Davis DR grading — 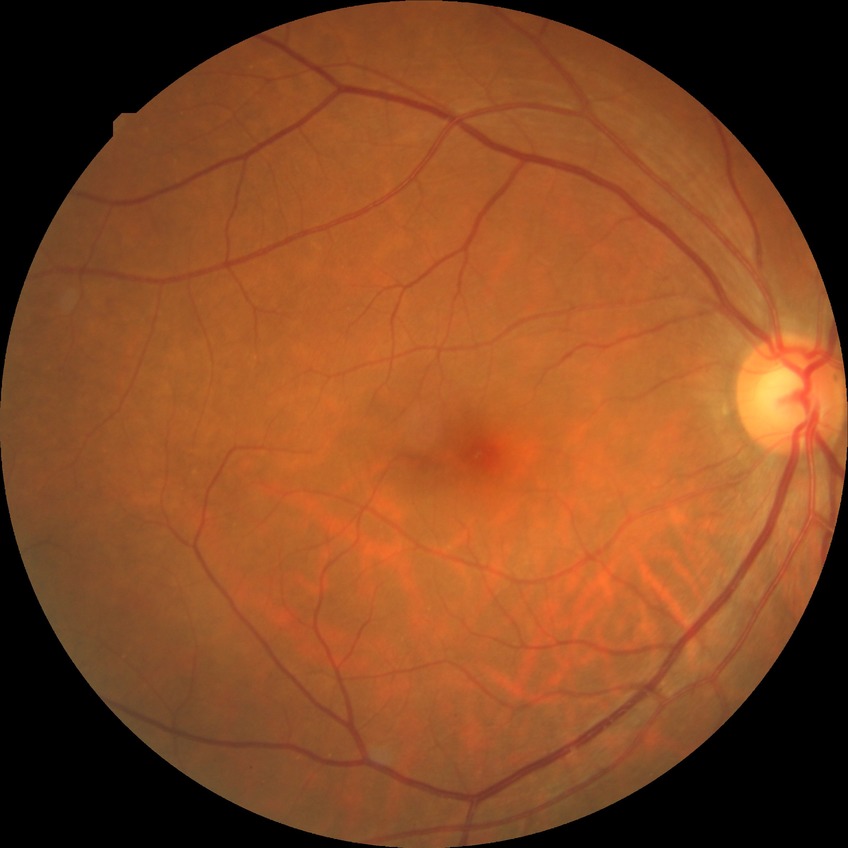 Davis grading is no diabetic retinopathy.